2352x1568px; FOV: 45 degrees:
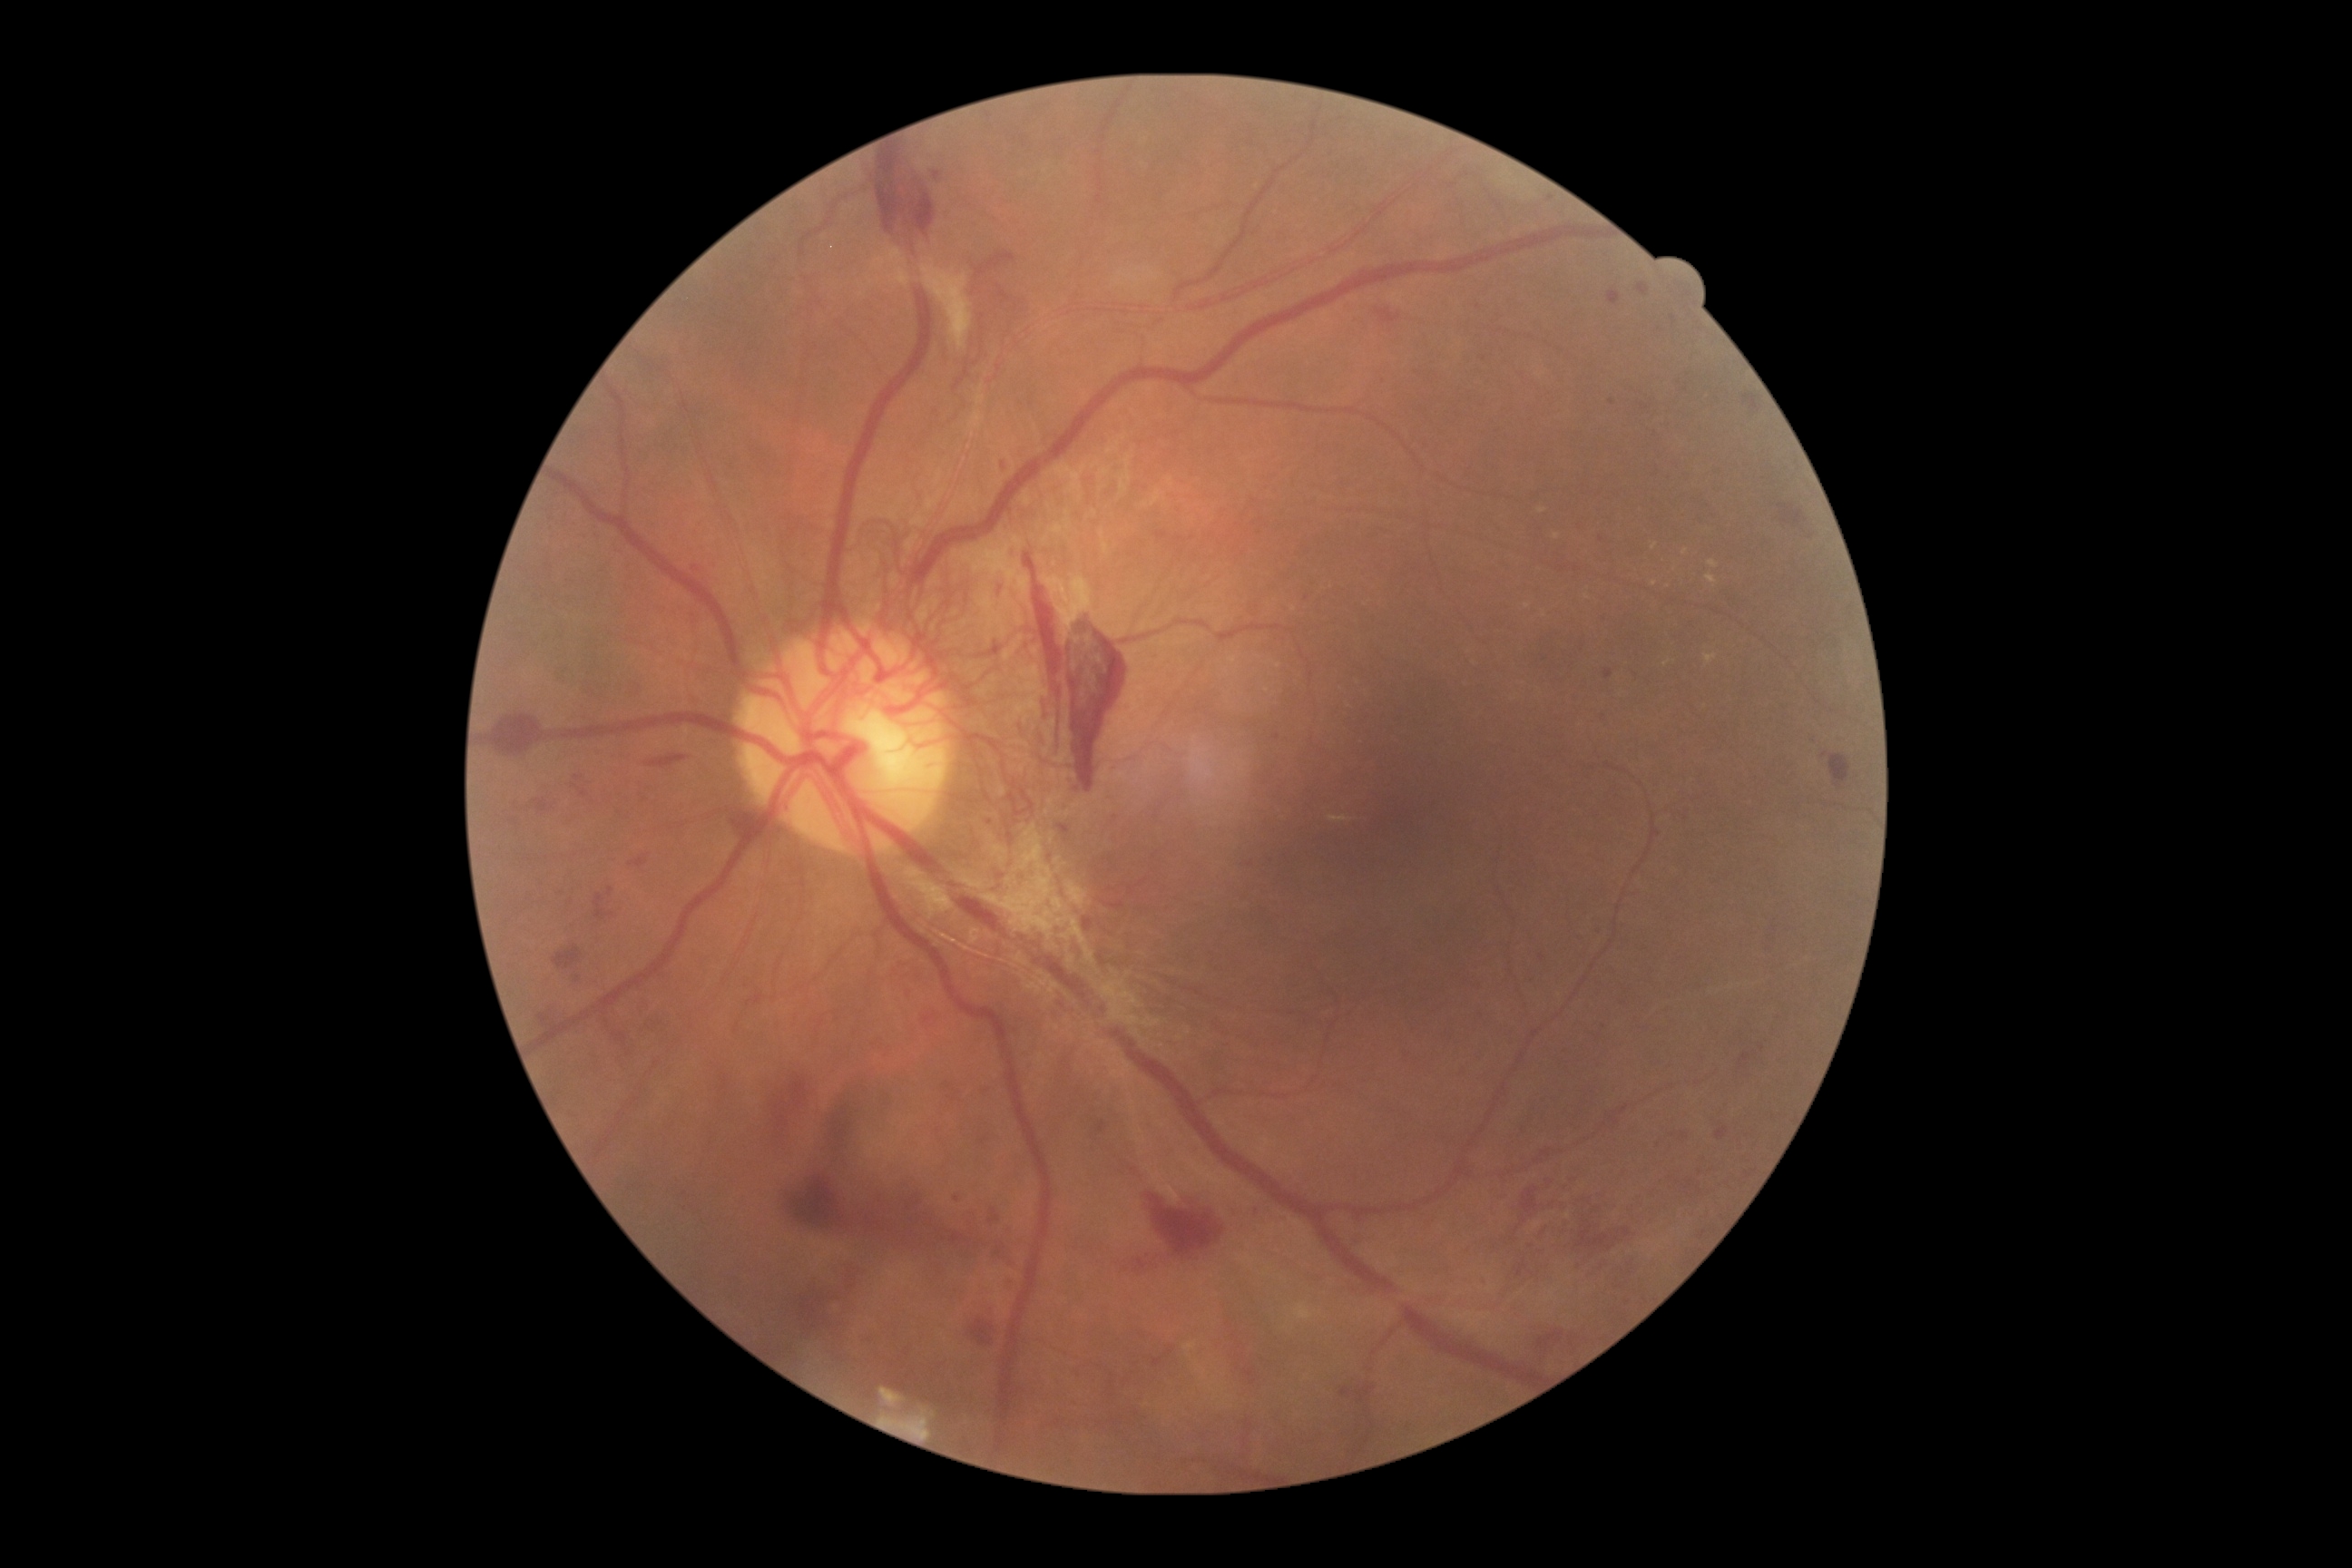 Diabetic retinopathy (DR): grade 4 (PDR); proliferative diabetic retinopathy
Representative lesions:
hemorrhages (HEs) (subset): 1821, 752, 1852, 792 | 1576, 1217, 1636, 1257 | 995, 284, 1014, 304 | 968, 1318, 995, 1346 | 883, 1357, 952, 1406 | 645, 754, 674, 770 | 847, 1275, 858, 1291 | 995, 1244, 1006, 1257 | 975, 1240, 983, 1246 | 865, 1217, 887, 1231 | 1146, 1193, 1226, 1260 | 1377, 309, 1402, 326 | 1340, 1382, 1378, 1411 | 1514, 1260, 1529, 1279 | 1536, 1329, 1565, 1357
Additional small HEs near x=956 y=1199 | x=921 y=1246 | x=1619 y=1287 | x=1550 y=1183